45° FOV — 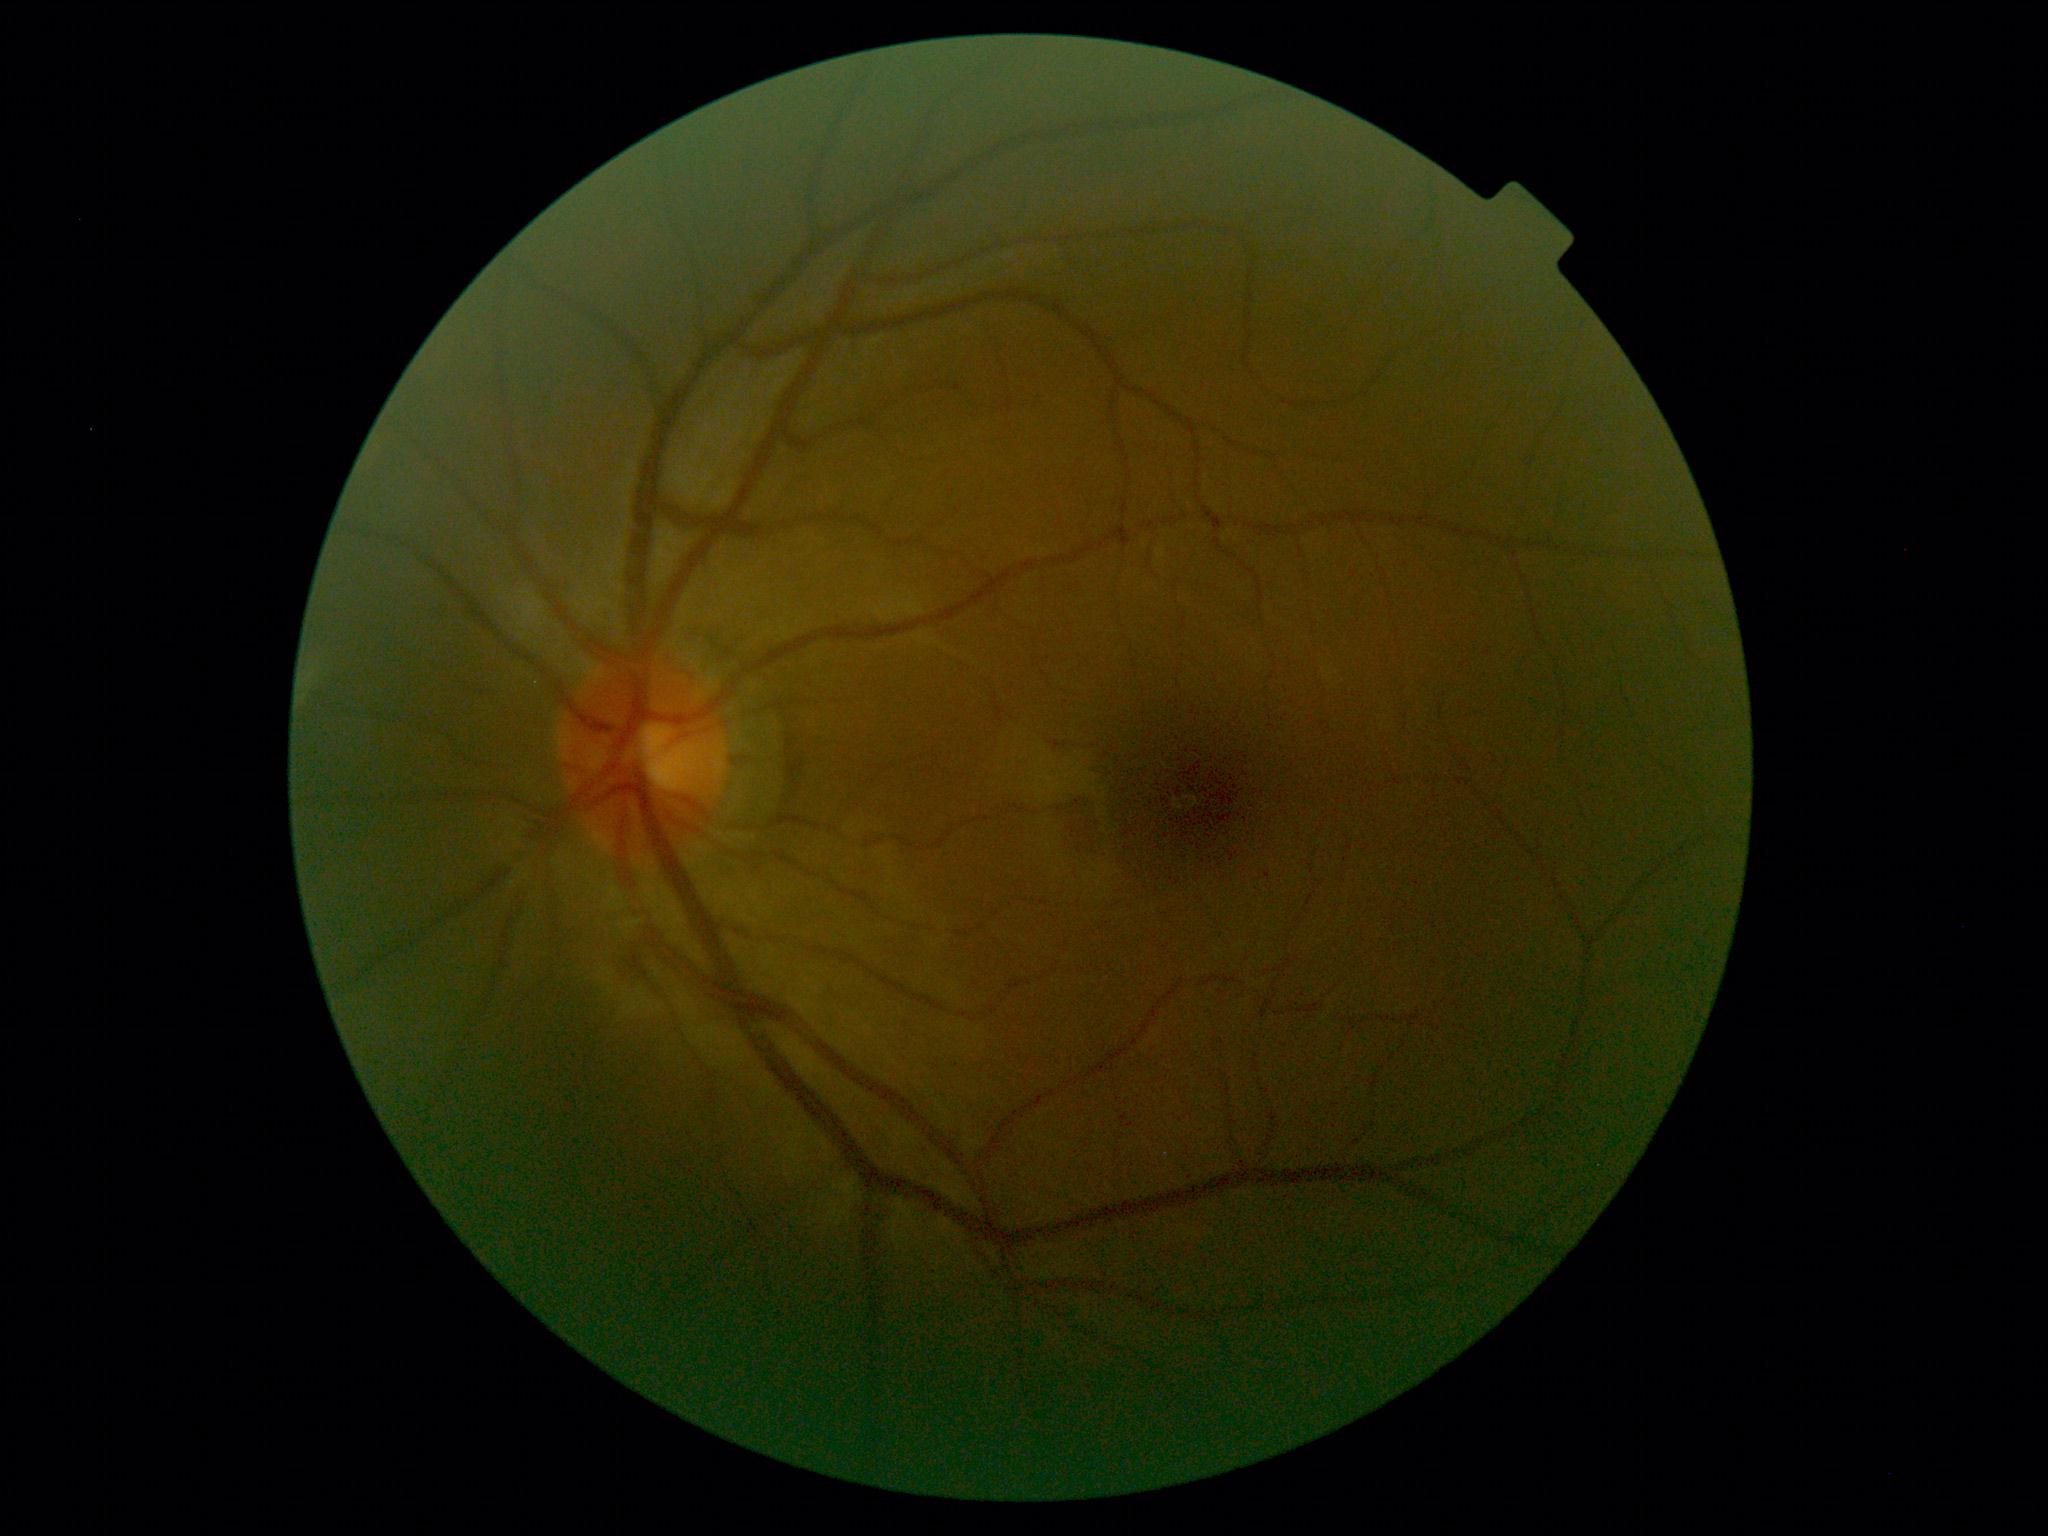 Annotations:
- retinopathy grade — 0 (no apparent retinopathy) — no visible signs of diabetic retinopathy